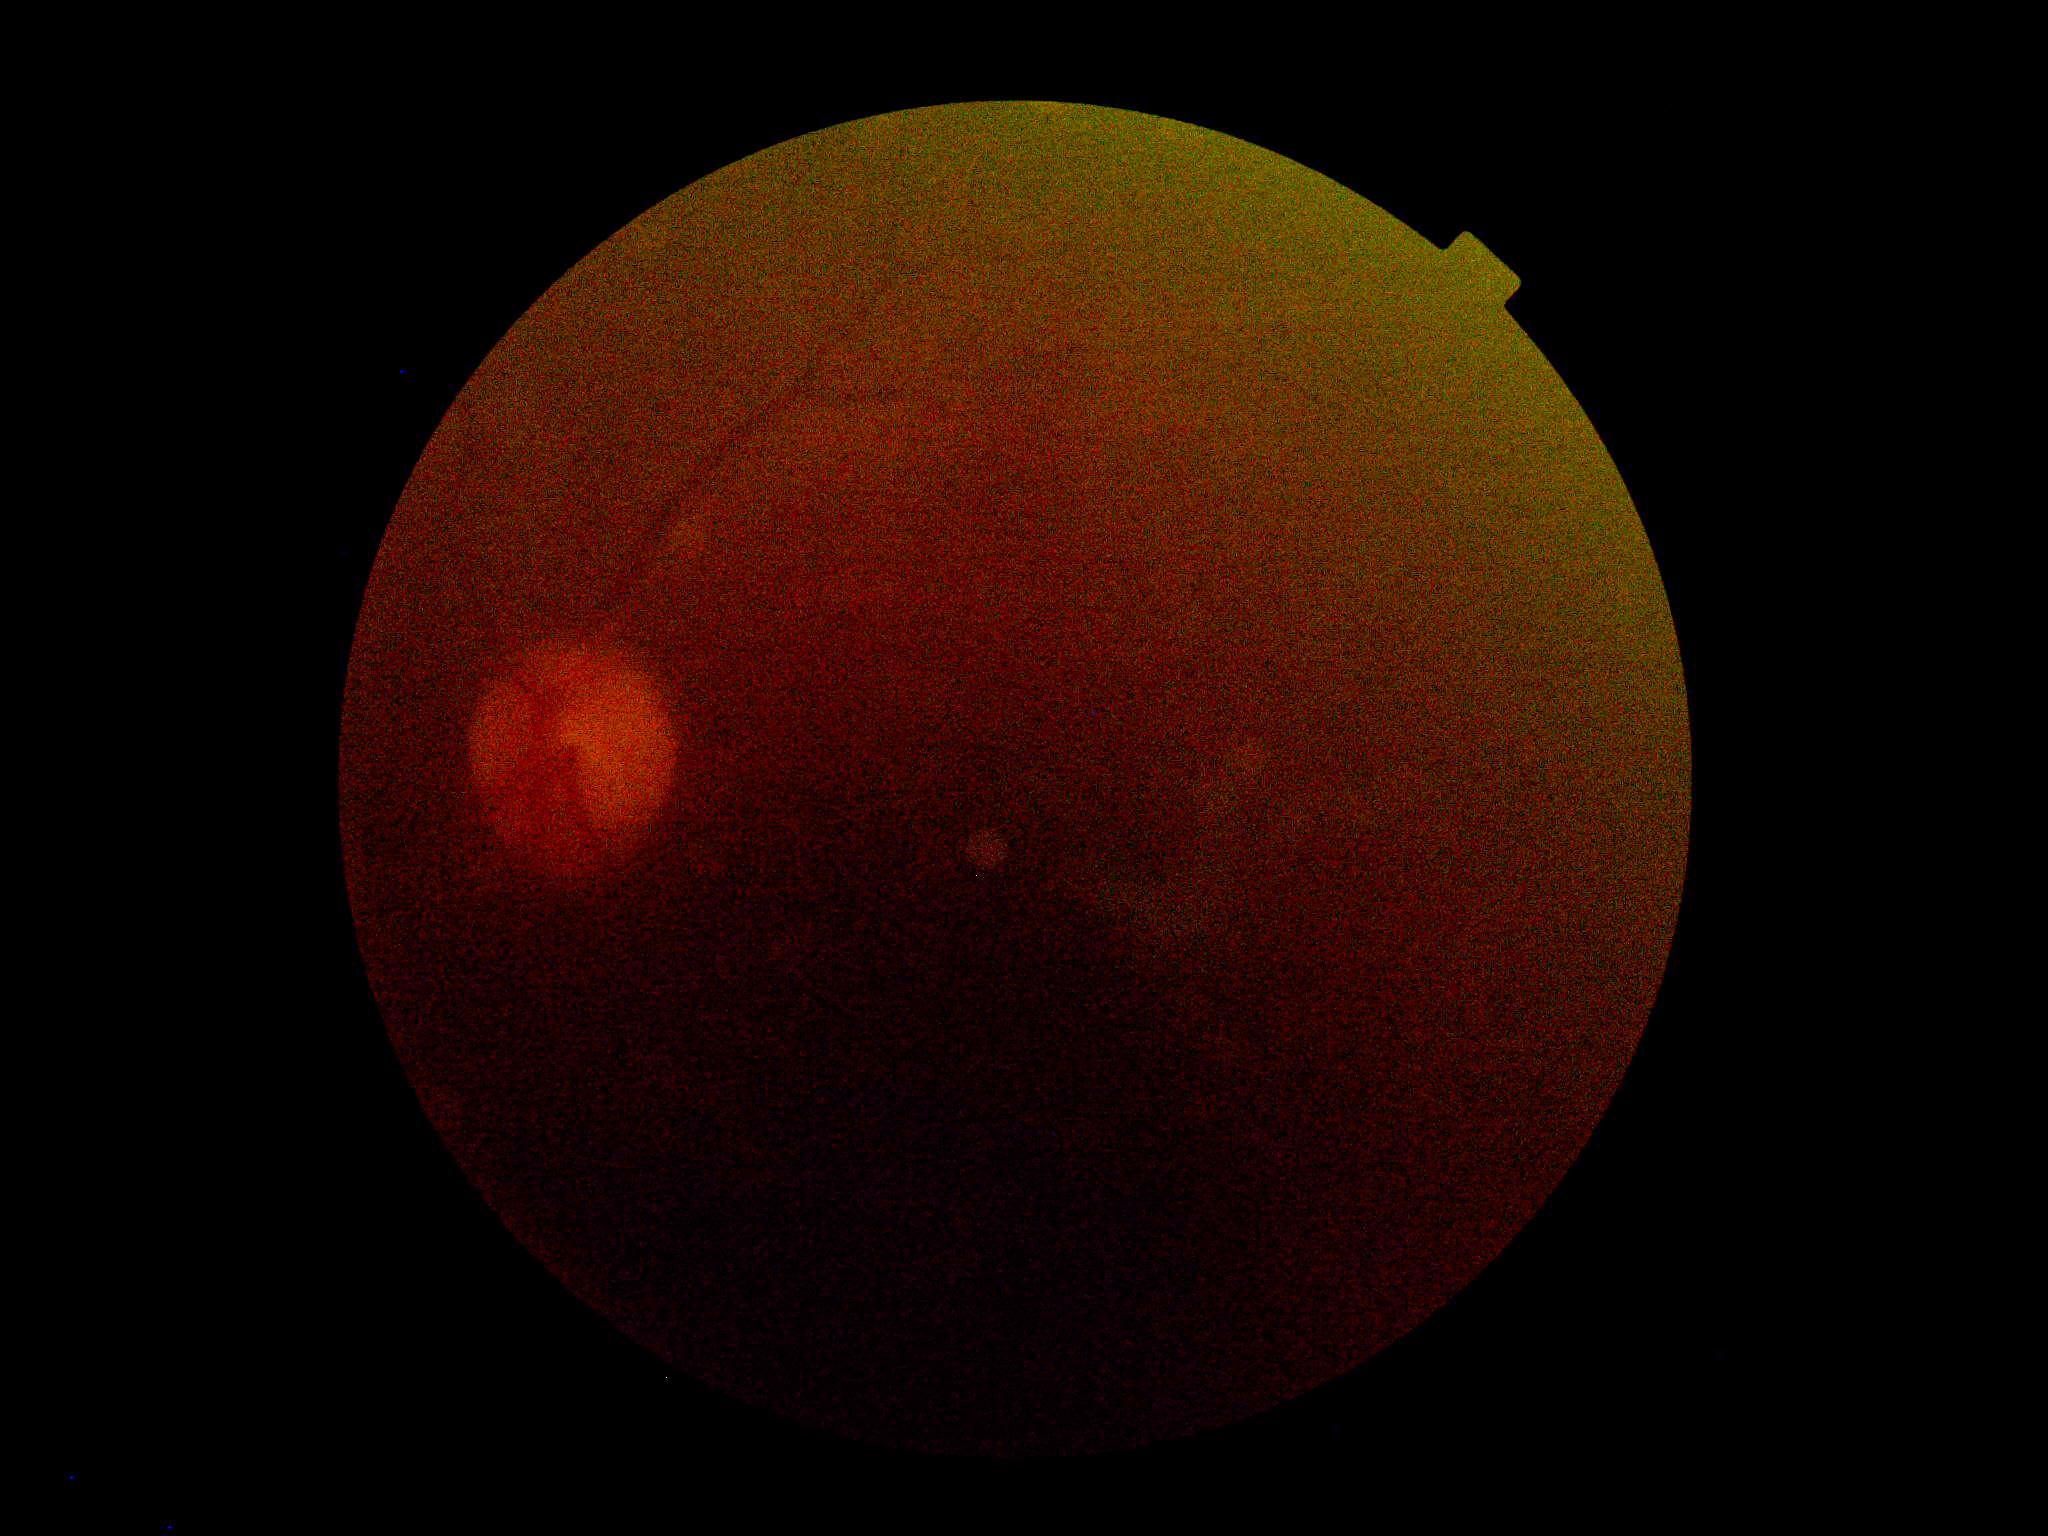

Diabetic retinopathy severity is ungradable due to poor image quality.